Color fundus image.
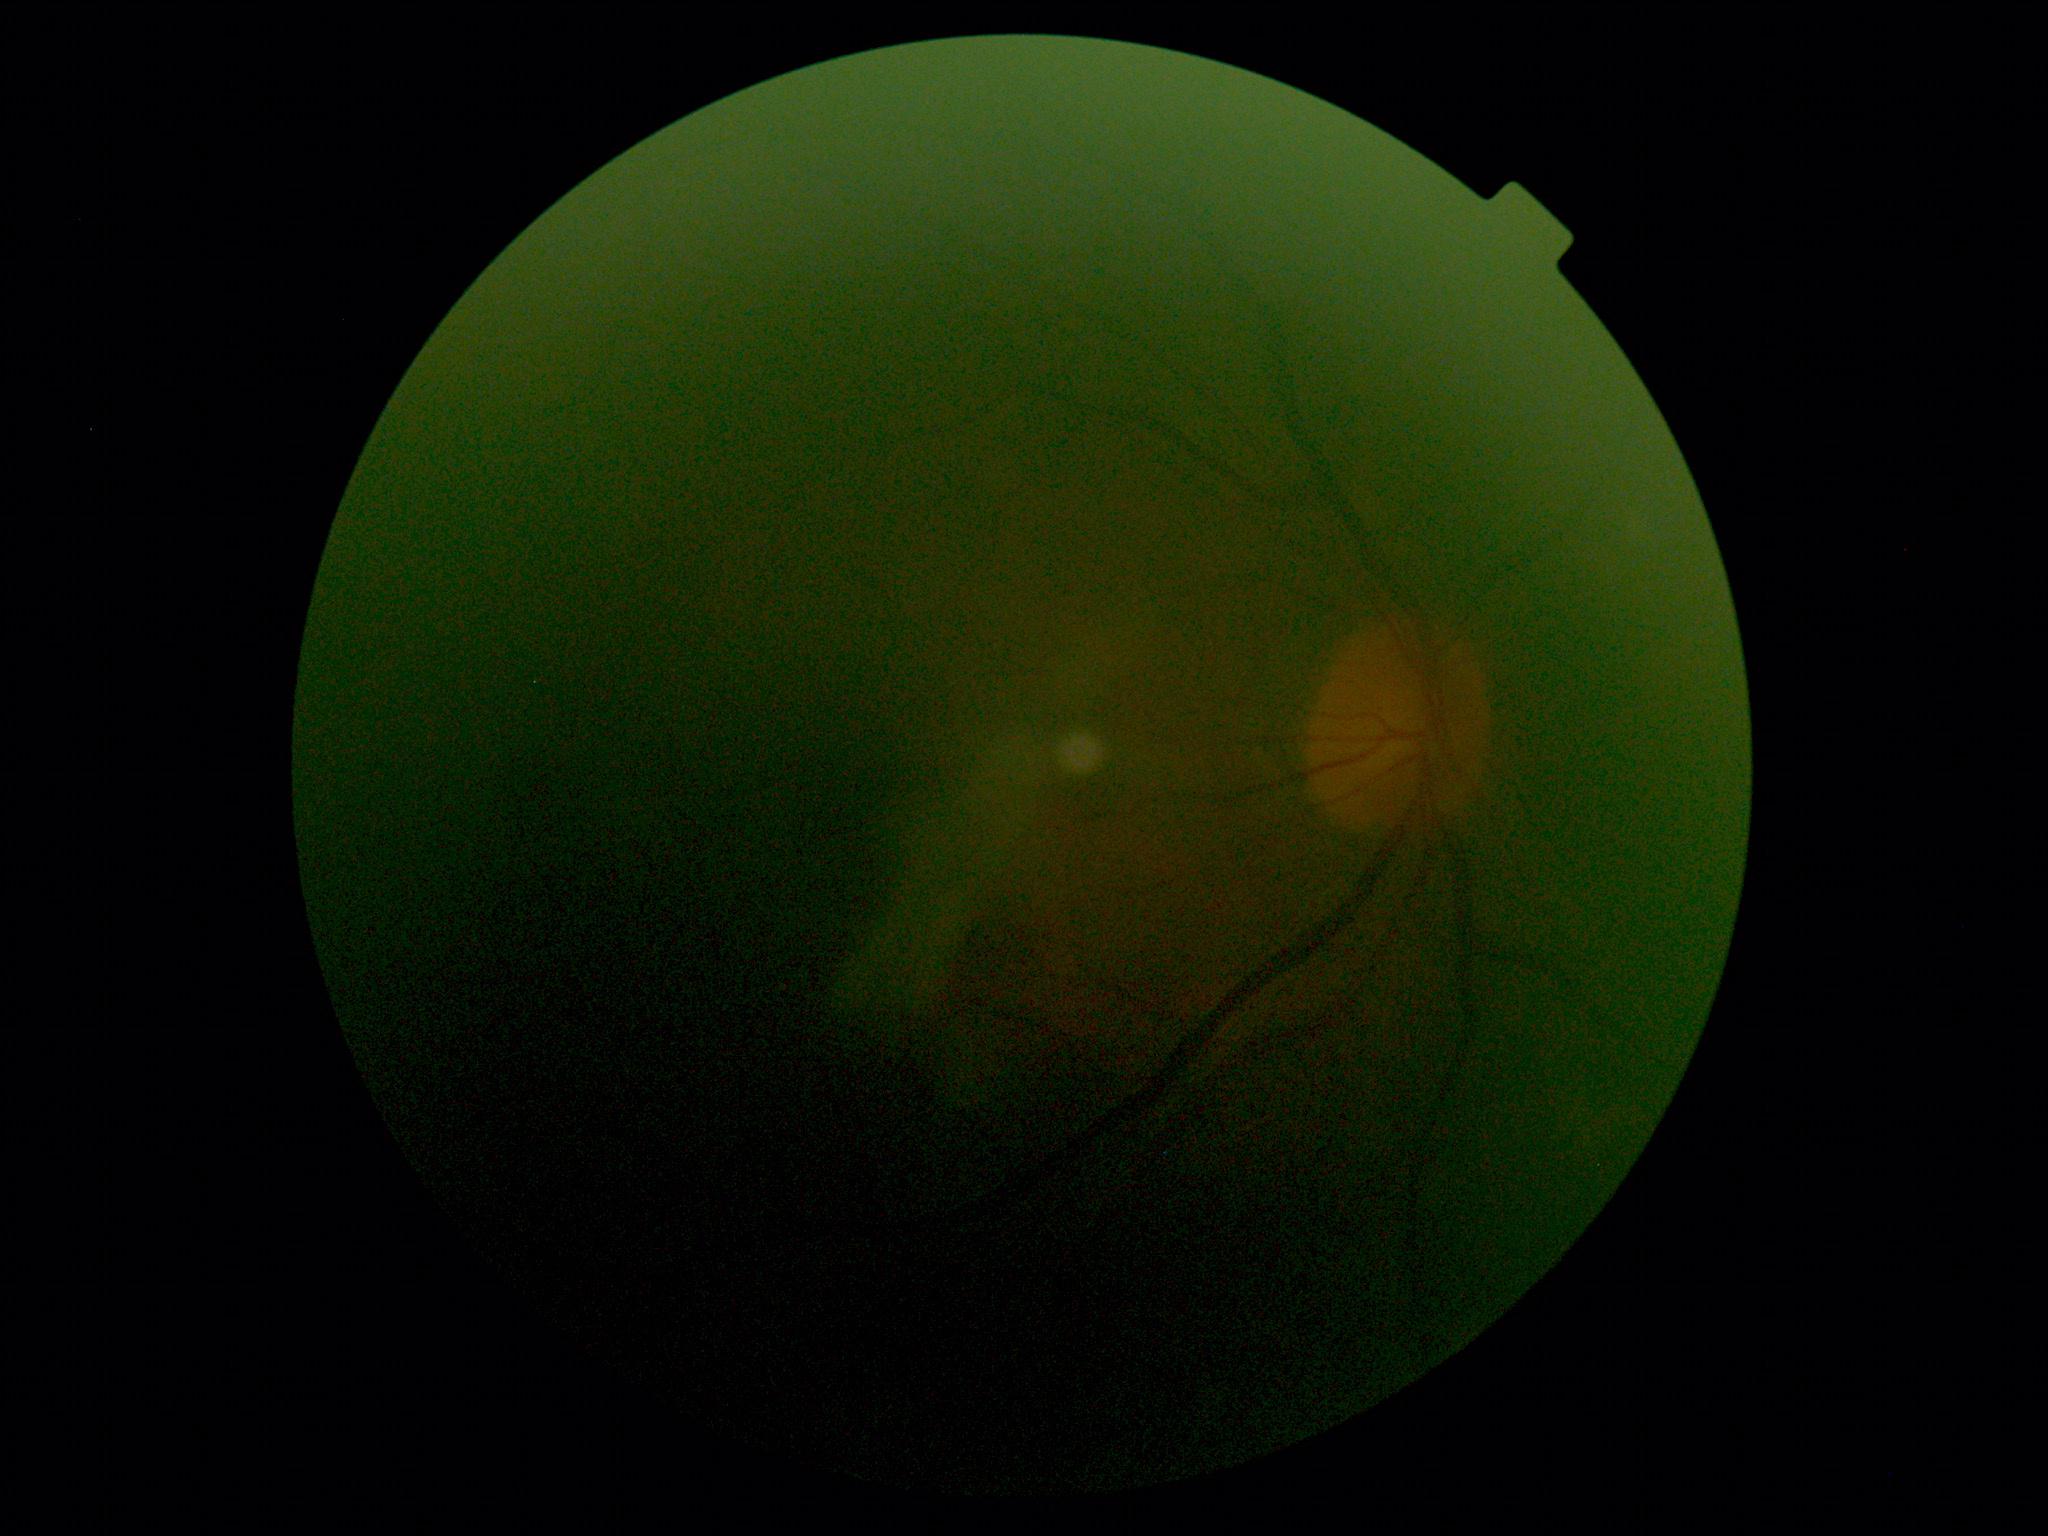
Quality too poor to assess for DR. DR is ungradable.